Modified Davis grading.
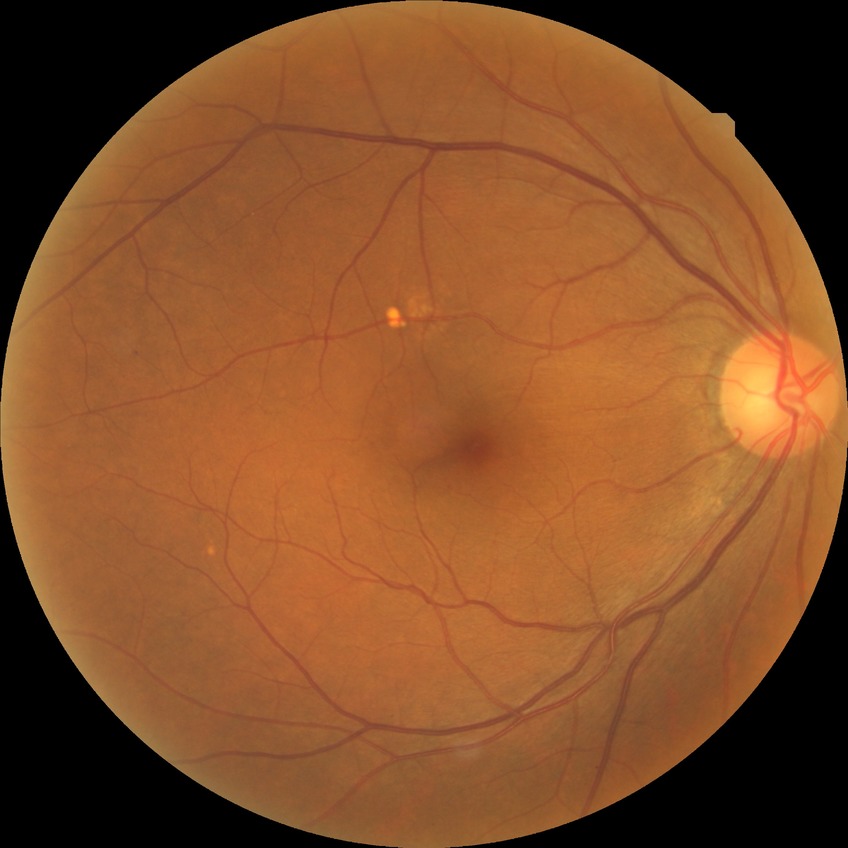
Diabetic retinopathy (DR): NDR (no diabetic retinopathy).